Wide-field fundus photograph from neonatal ROP screening · acquired on the Clarity RetCam 3 · image size 640x480: 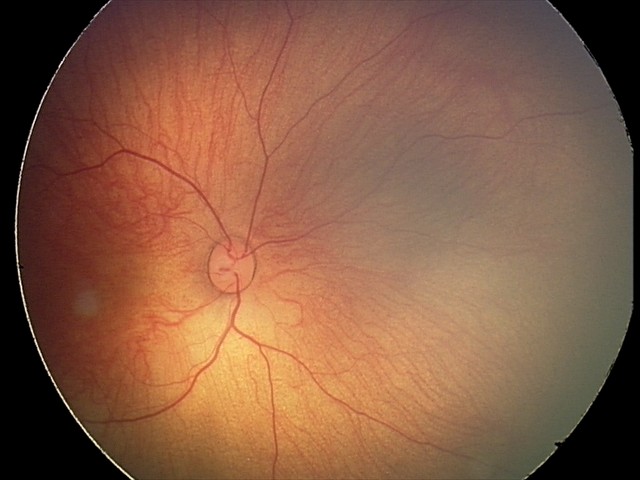
From an examination with diagnosis of retinal hemorrhages.